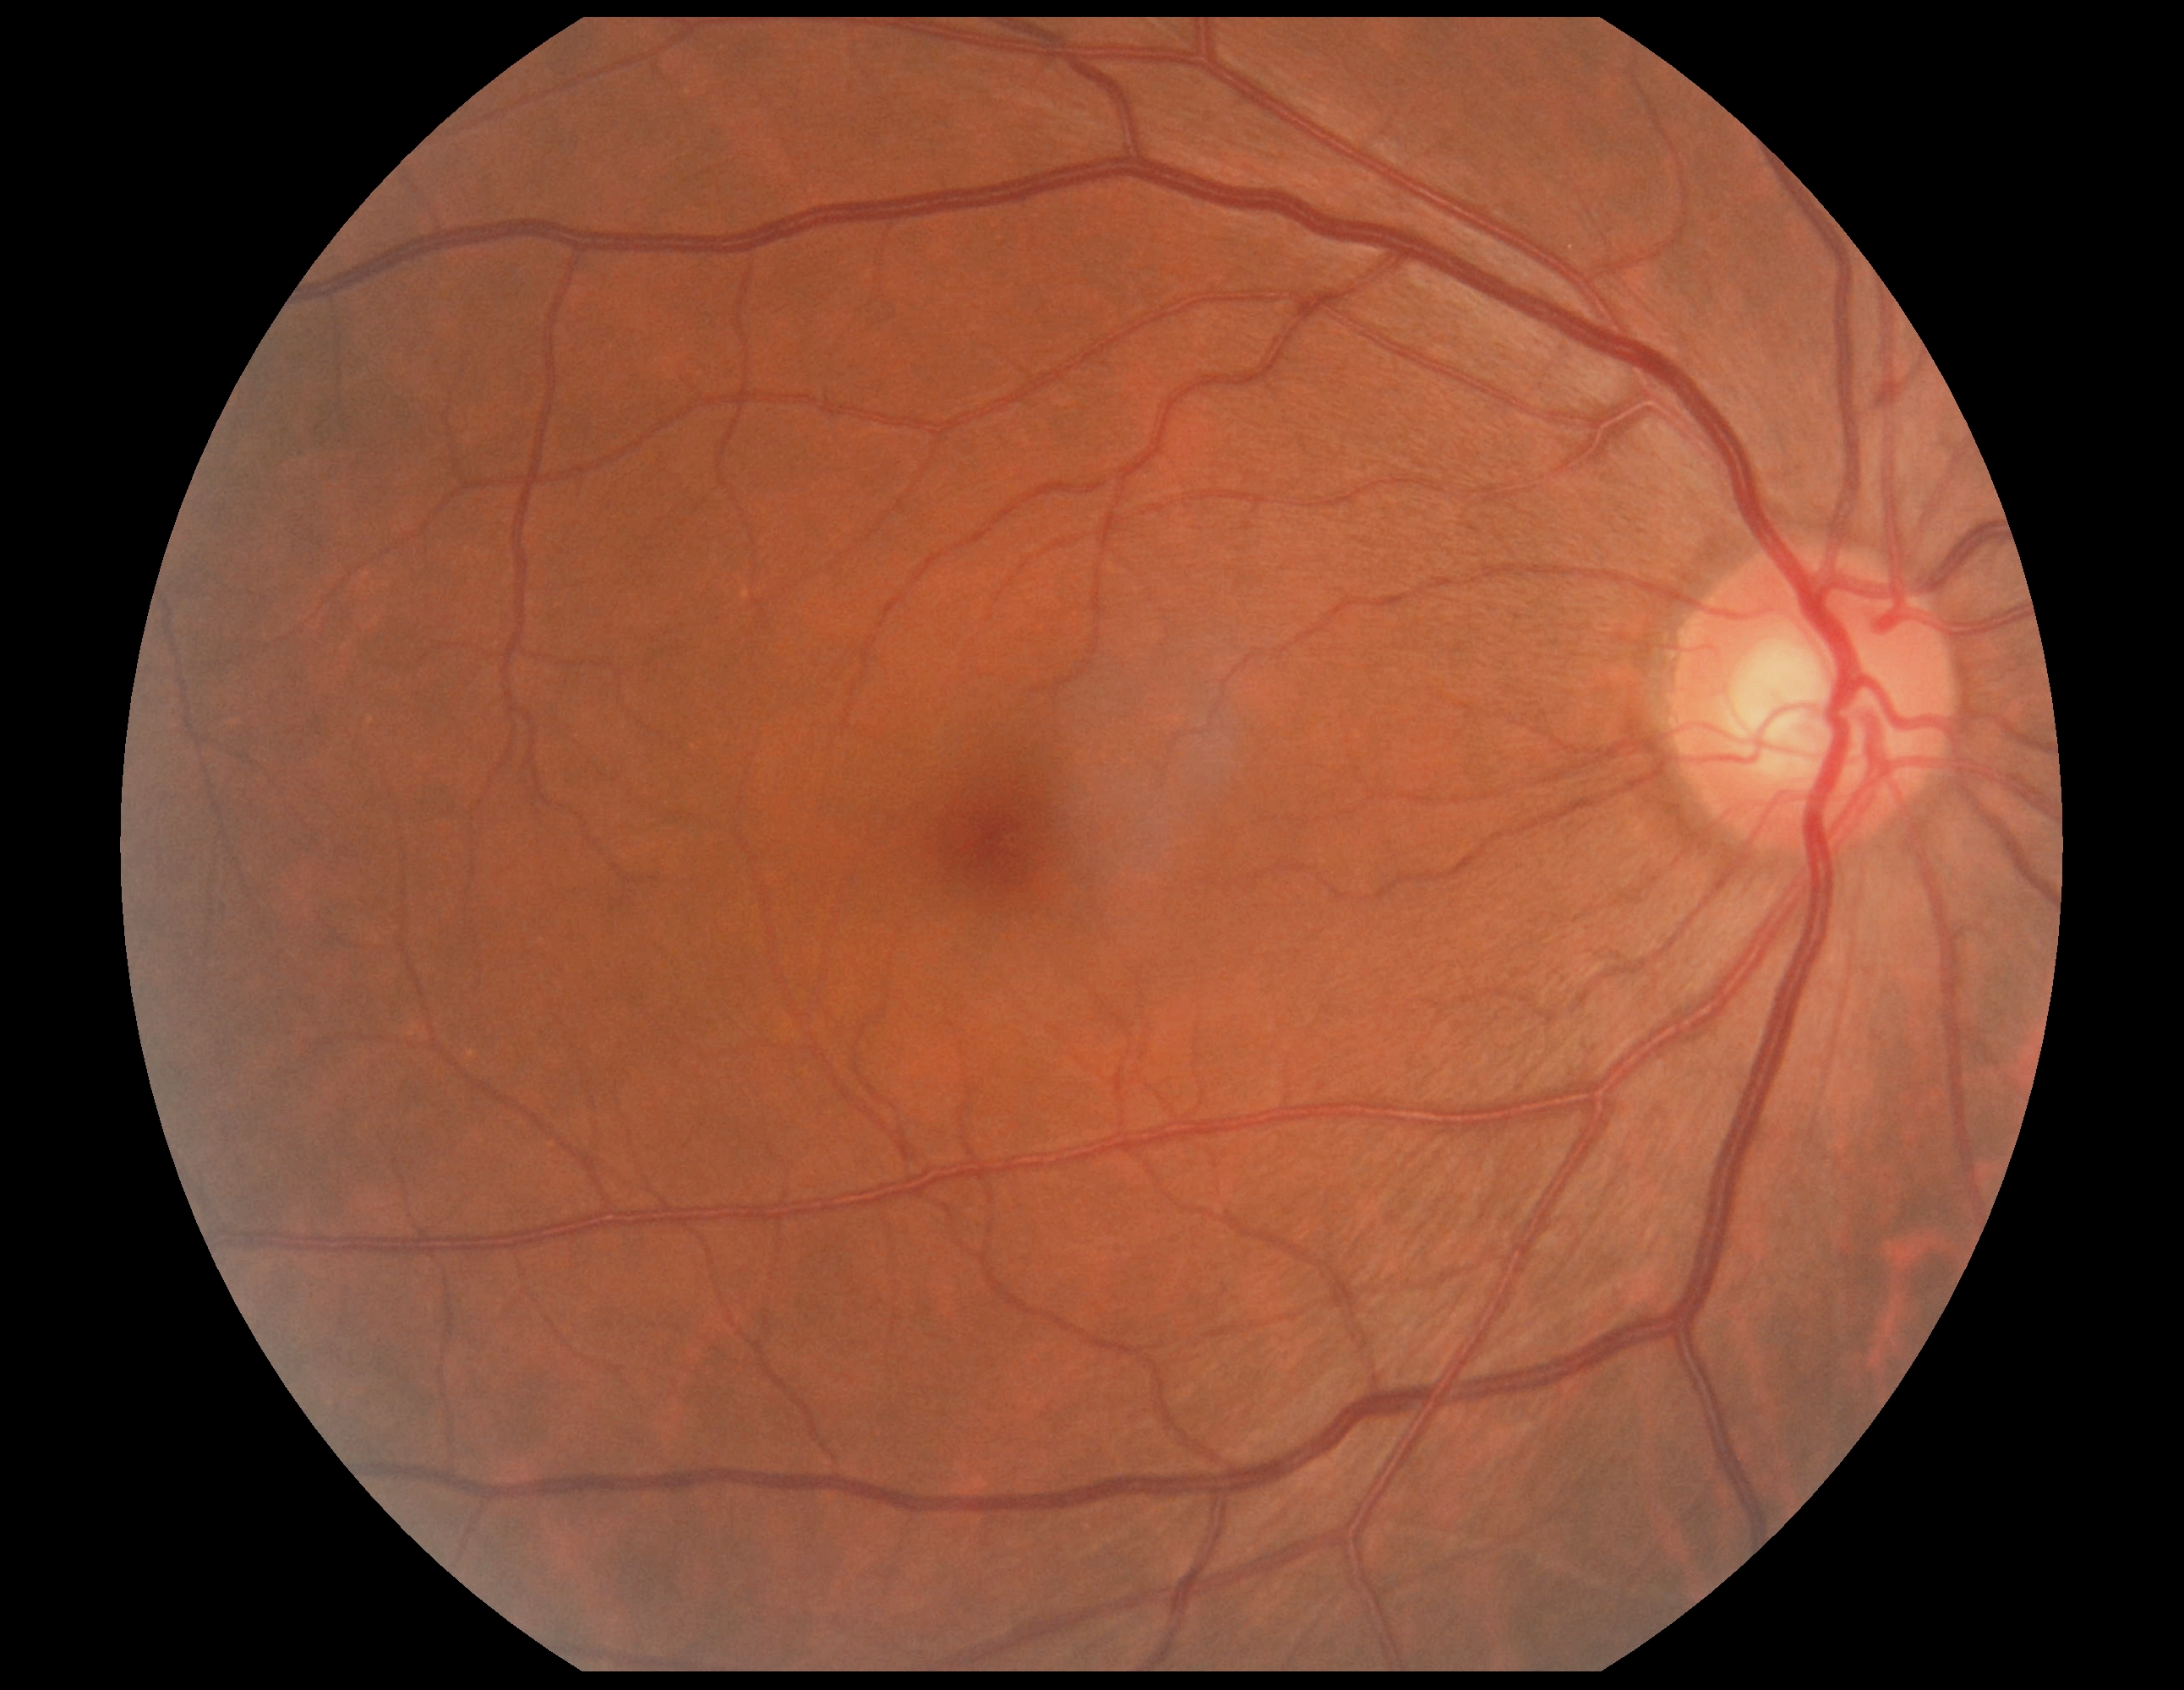
{
  "dr_grade": "no apparent diabetic retinopathy (0)",
  "dr_impression": "negative for DR"
}